1240x1240 · wide-field contact fundus photograph of an infant · camera: Phoenix ICON (100° FOV).
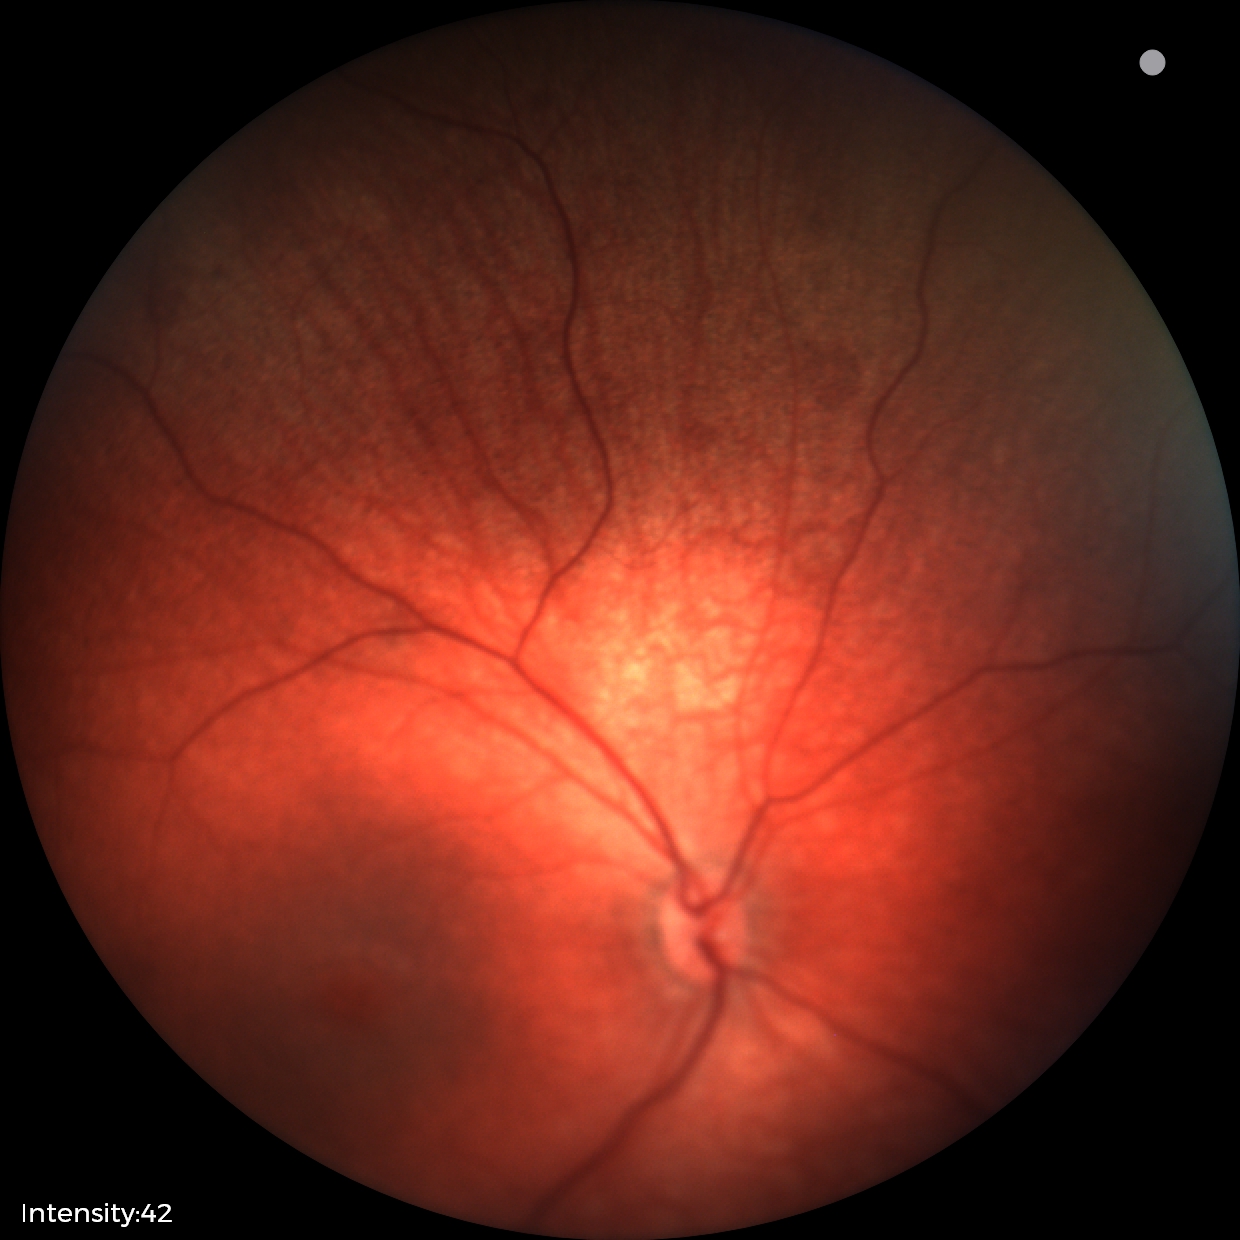
Screening: physiological retinal finding.